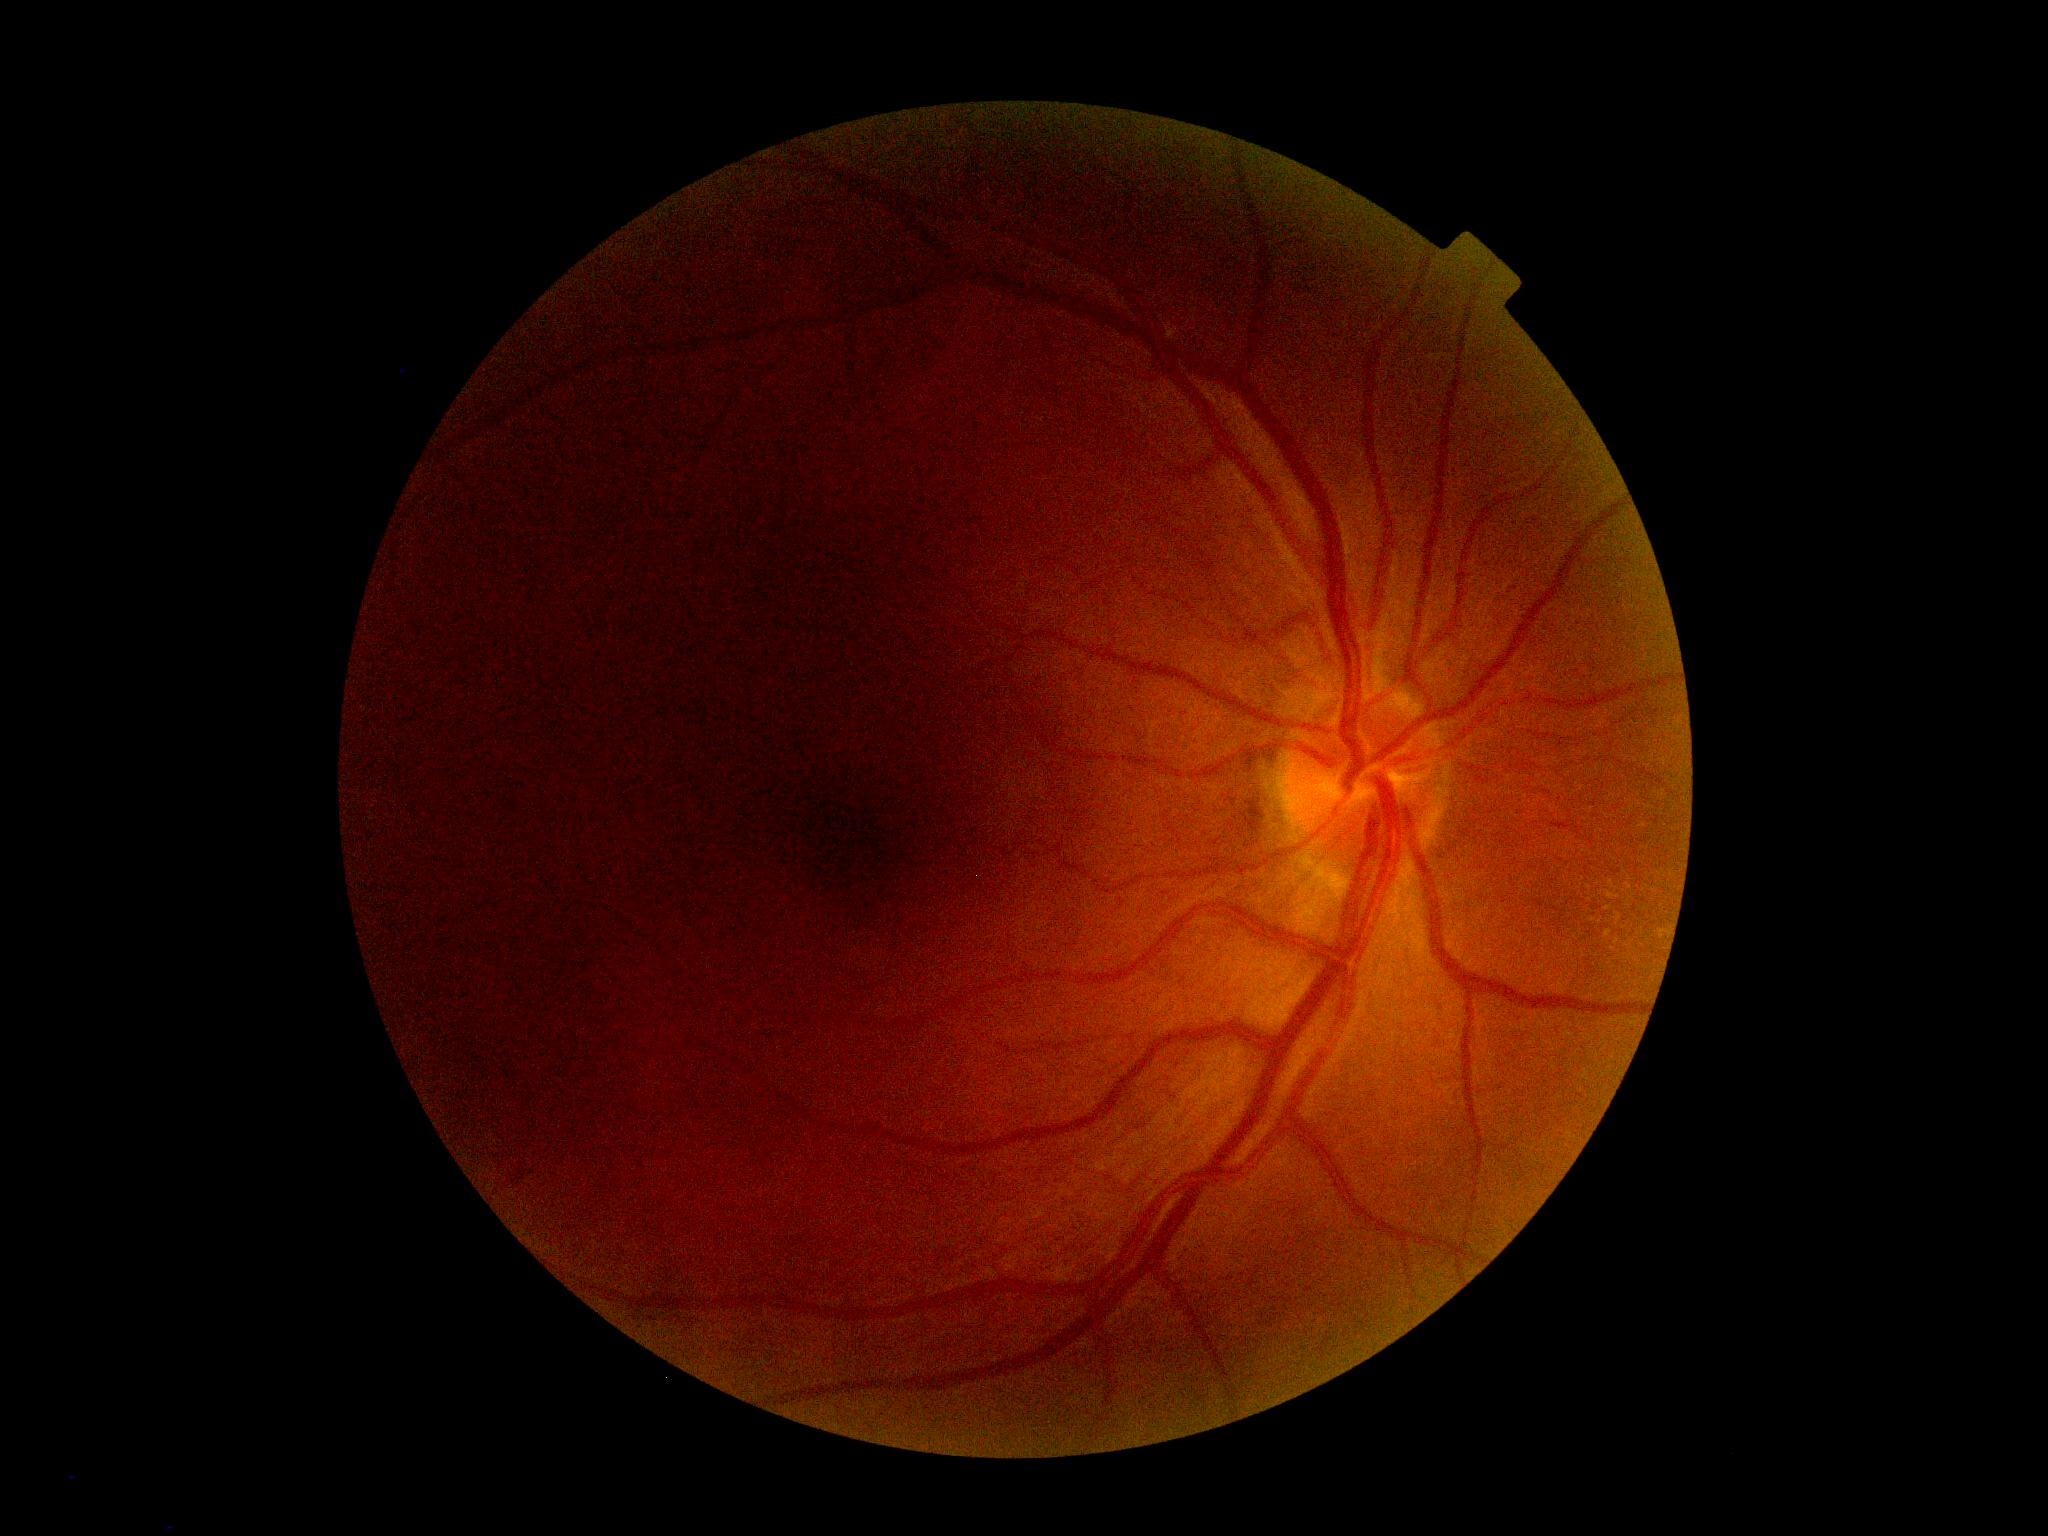
Diabetic retinopathy grade is moderate NPDR (2).